No pharmacologic dilation · graded on the modified Davis scale · 848x848: 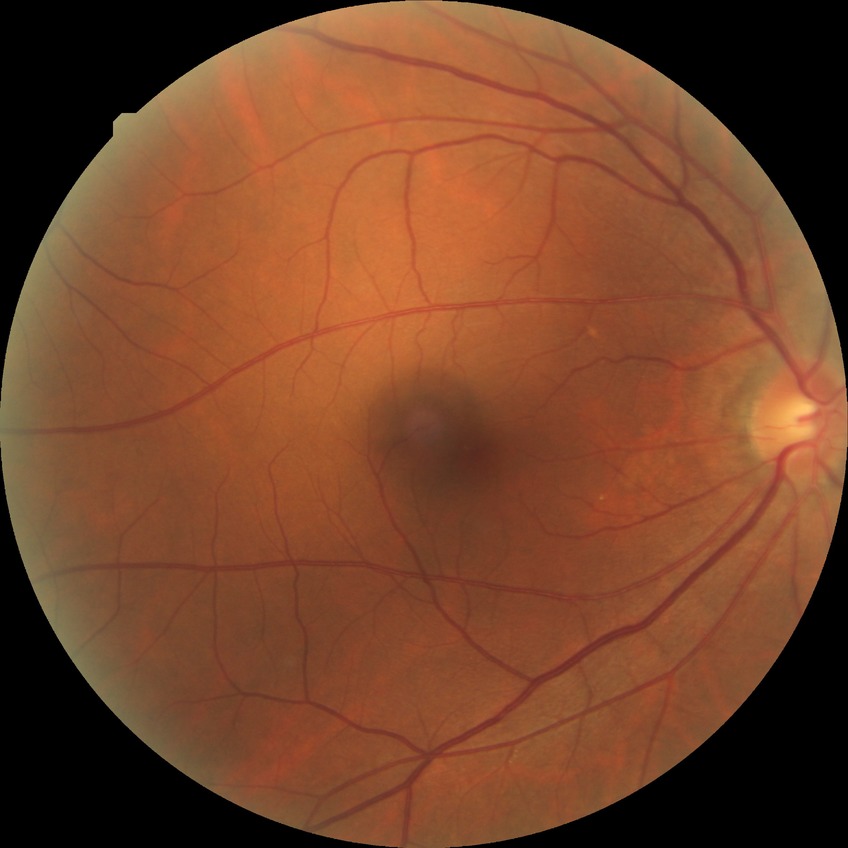 Retinopathy stage is no diabetic retinopathy.